Retinal fundus photograph.
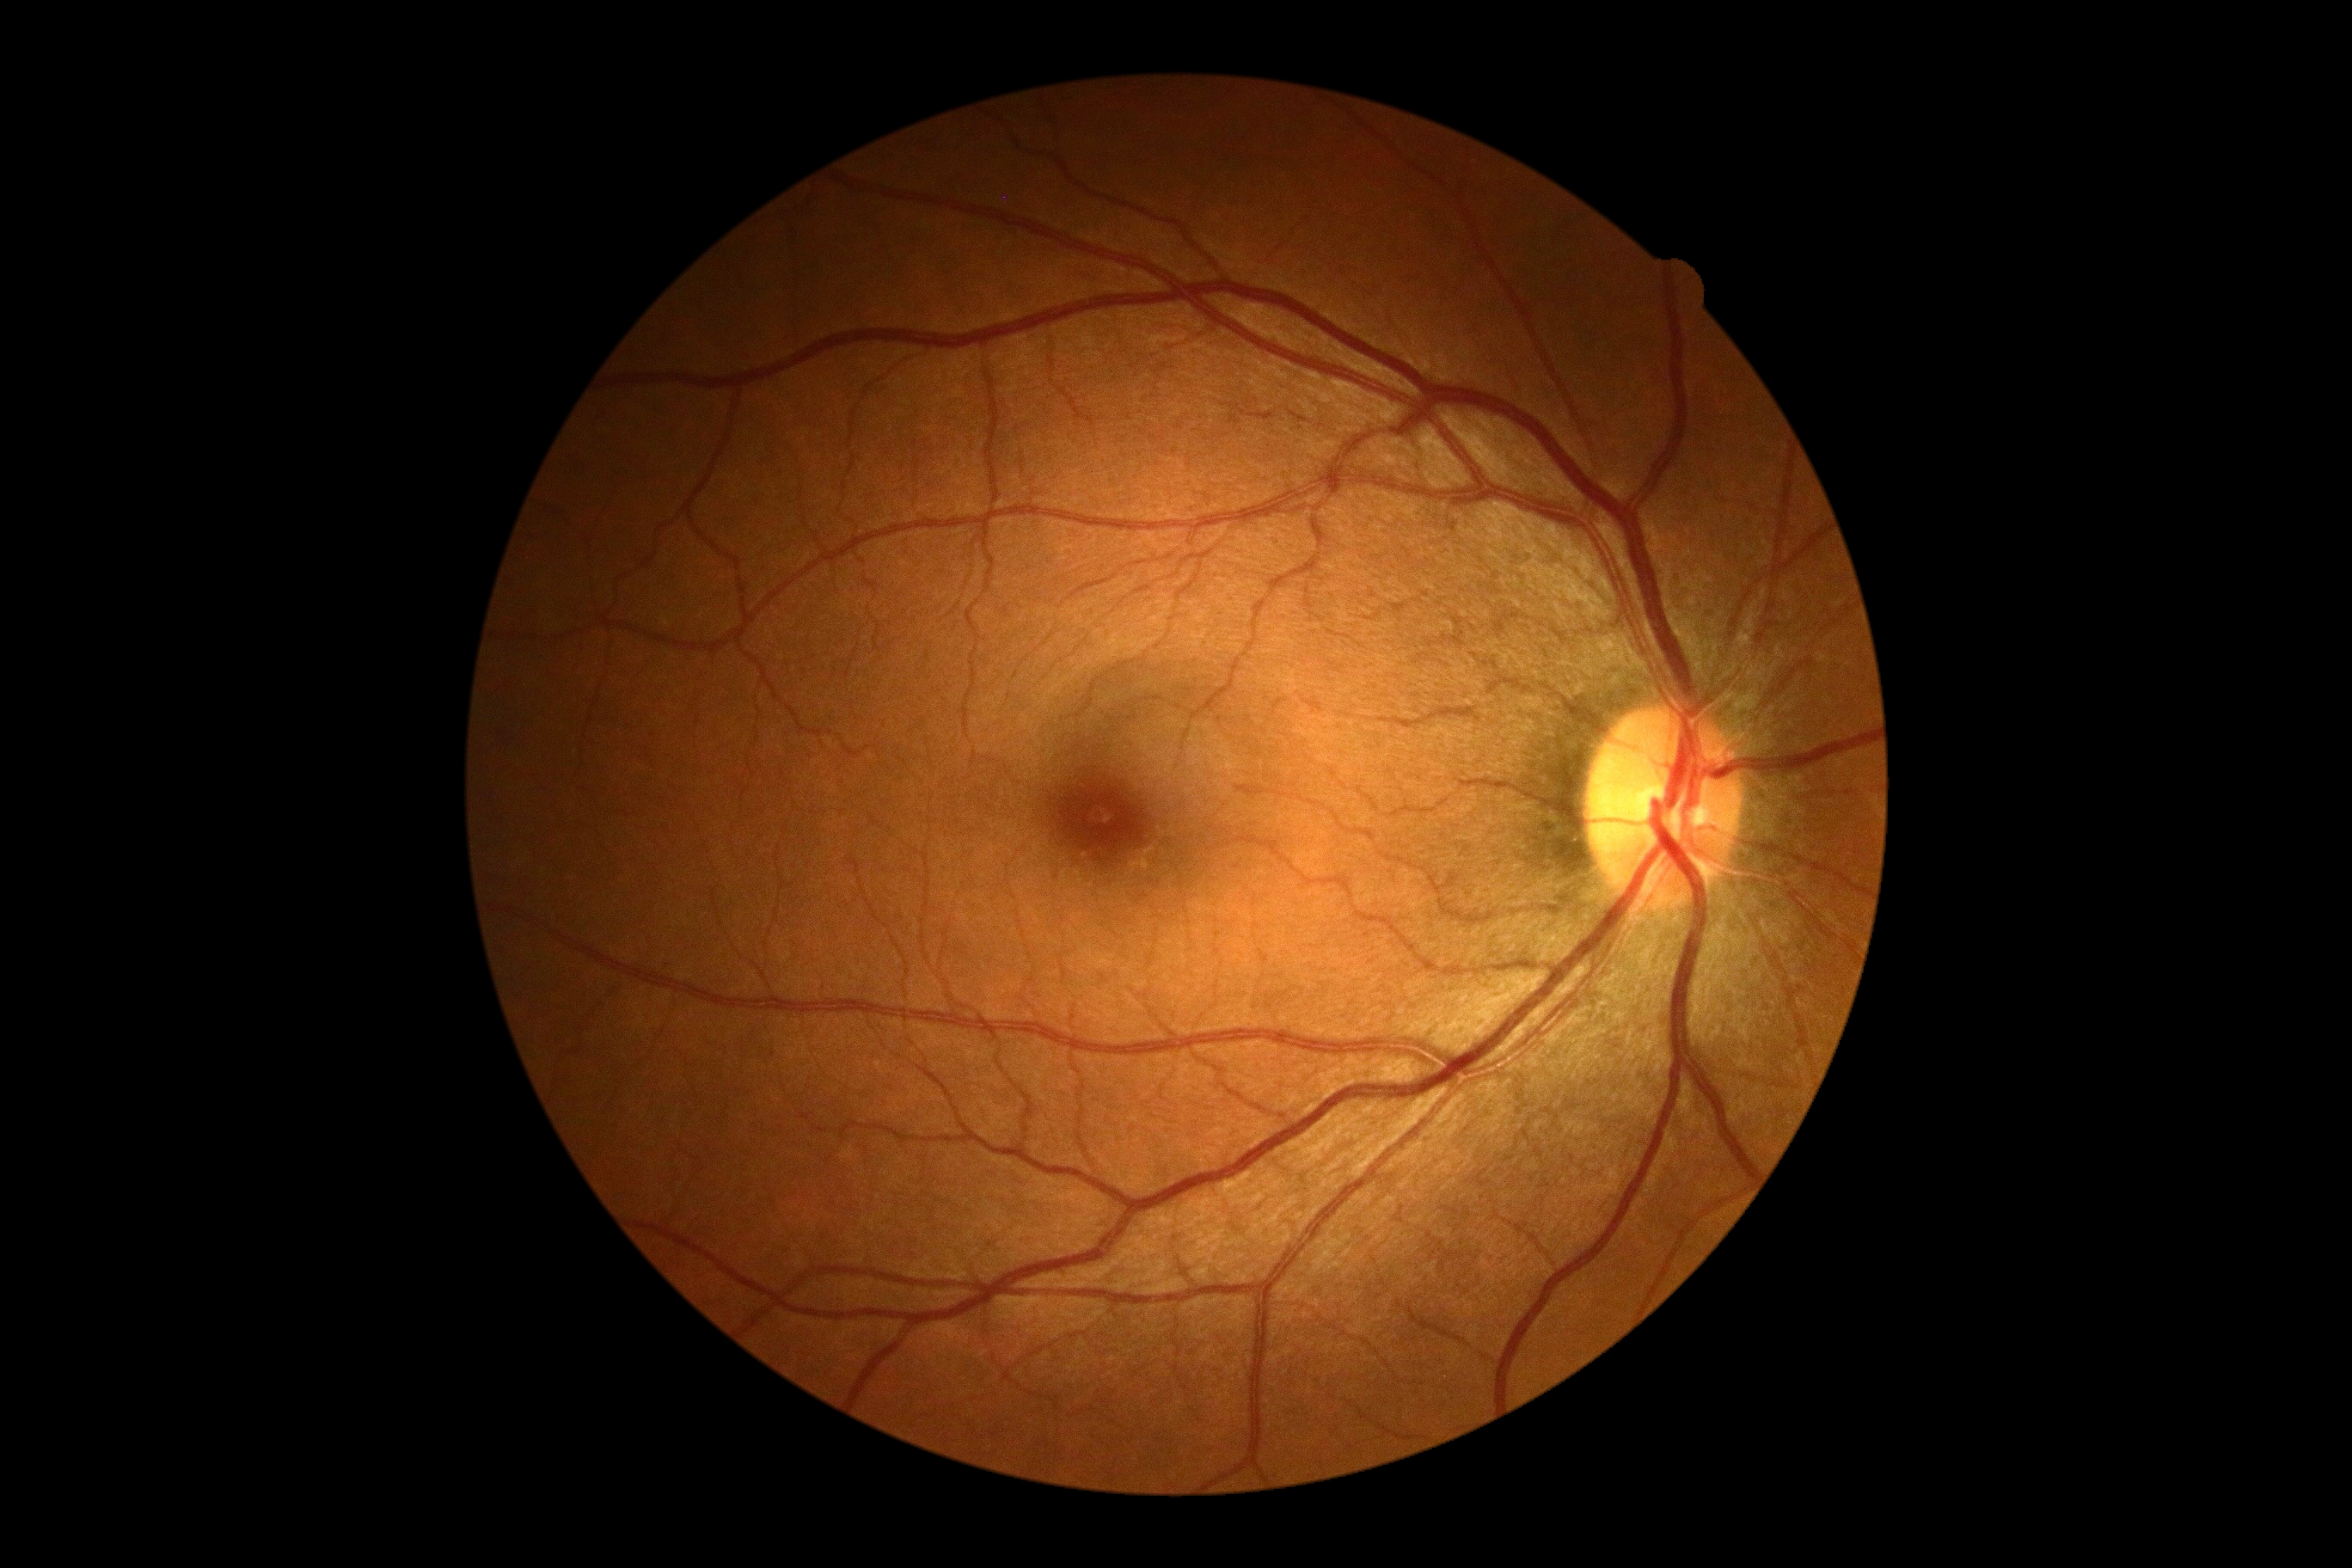

DR stage = no apparent retinopathy (grade 0).